FOV: 45 degrees
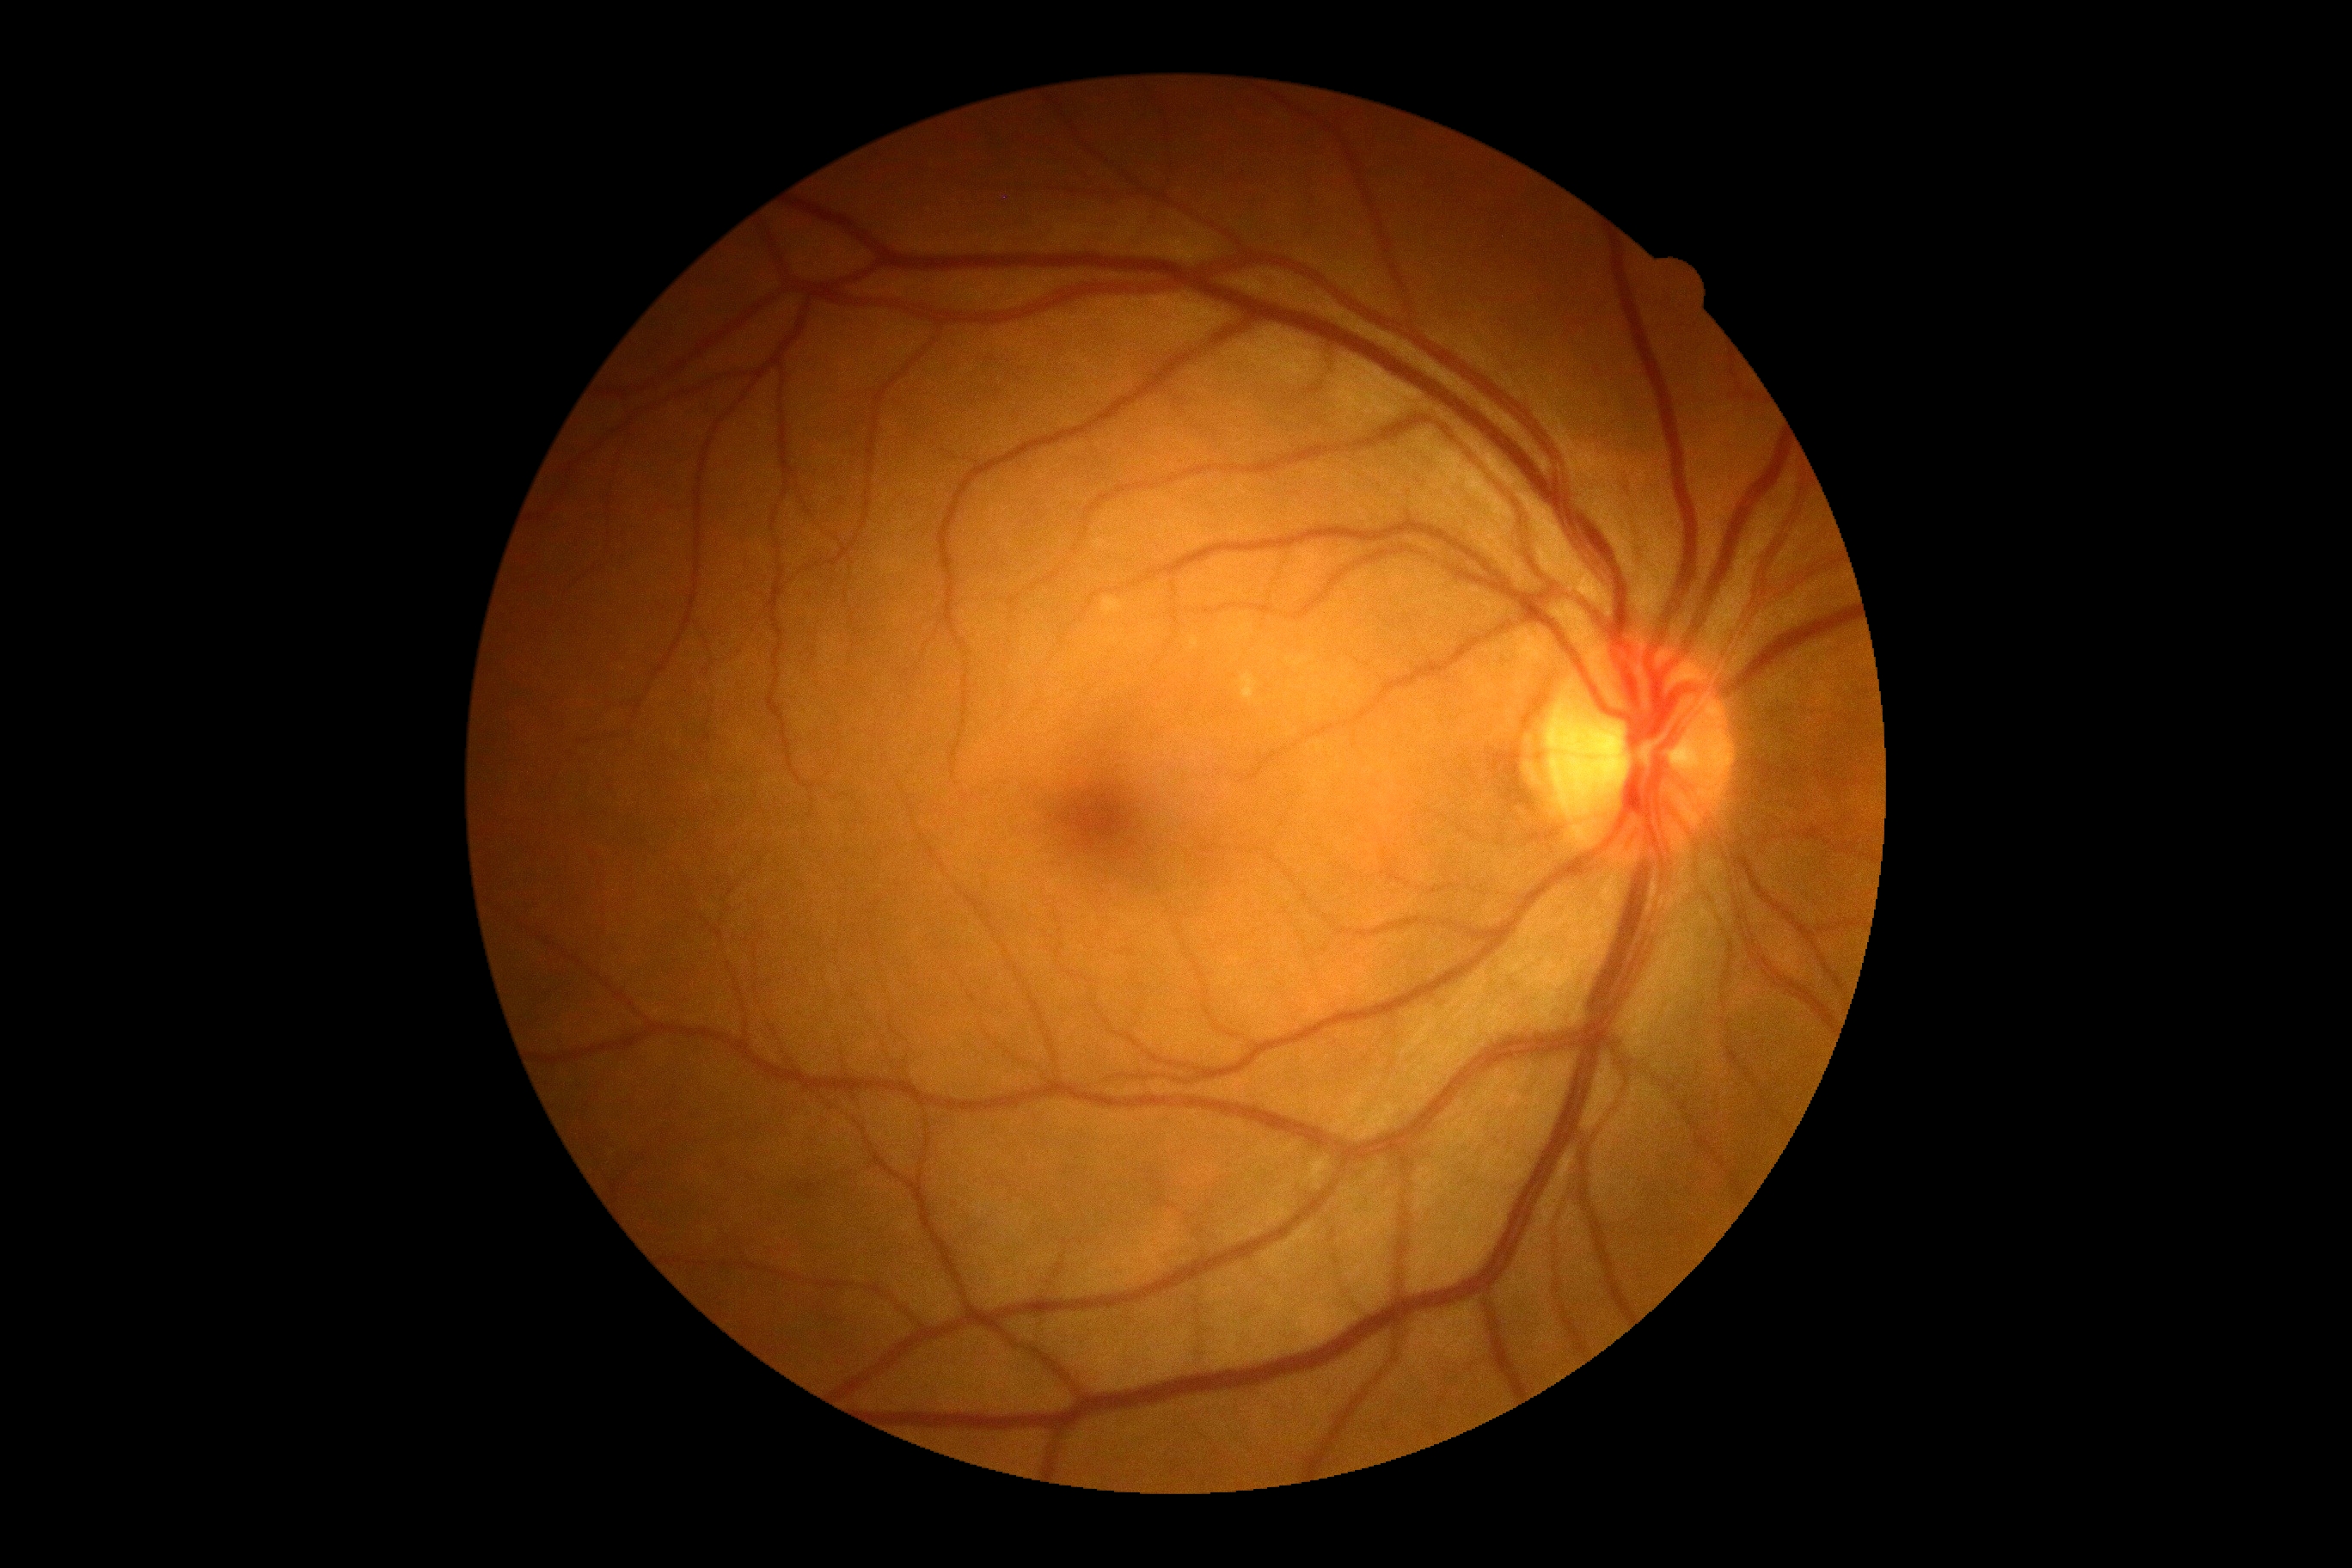
DR severity: 0 — no visible signs of diabetic retinopathy. No diabetic retinal disease findings.